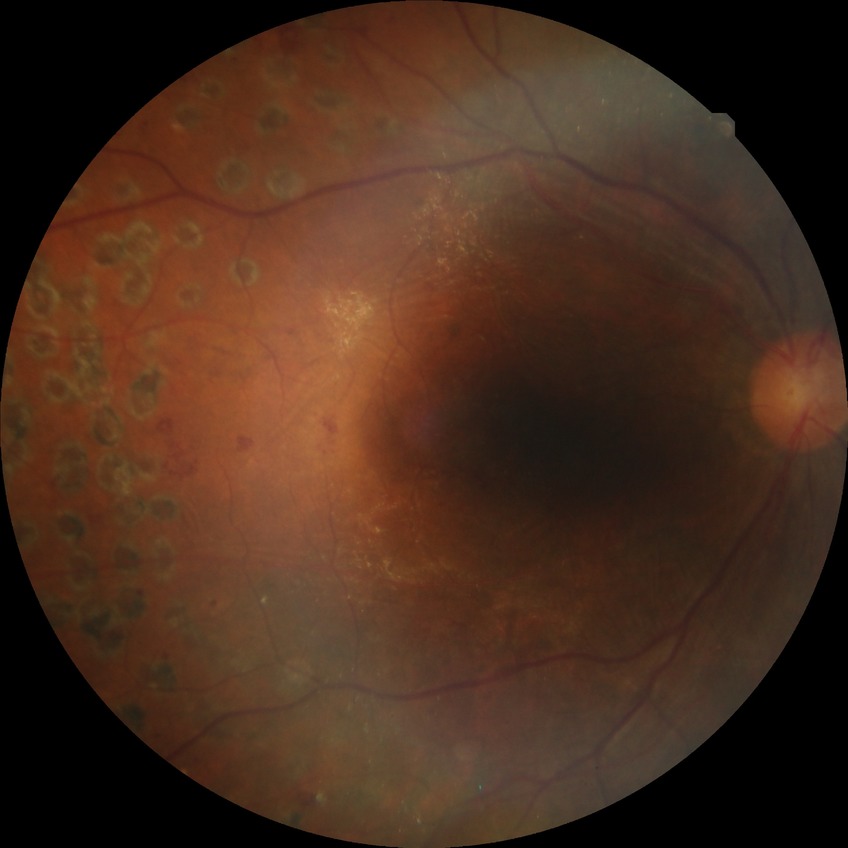 Retinopathy grade: proliferative diabetic retinopathy.